45° field of view.
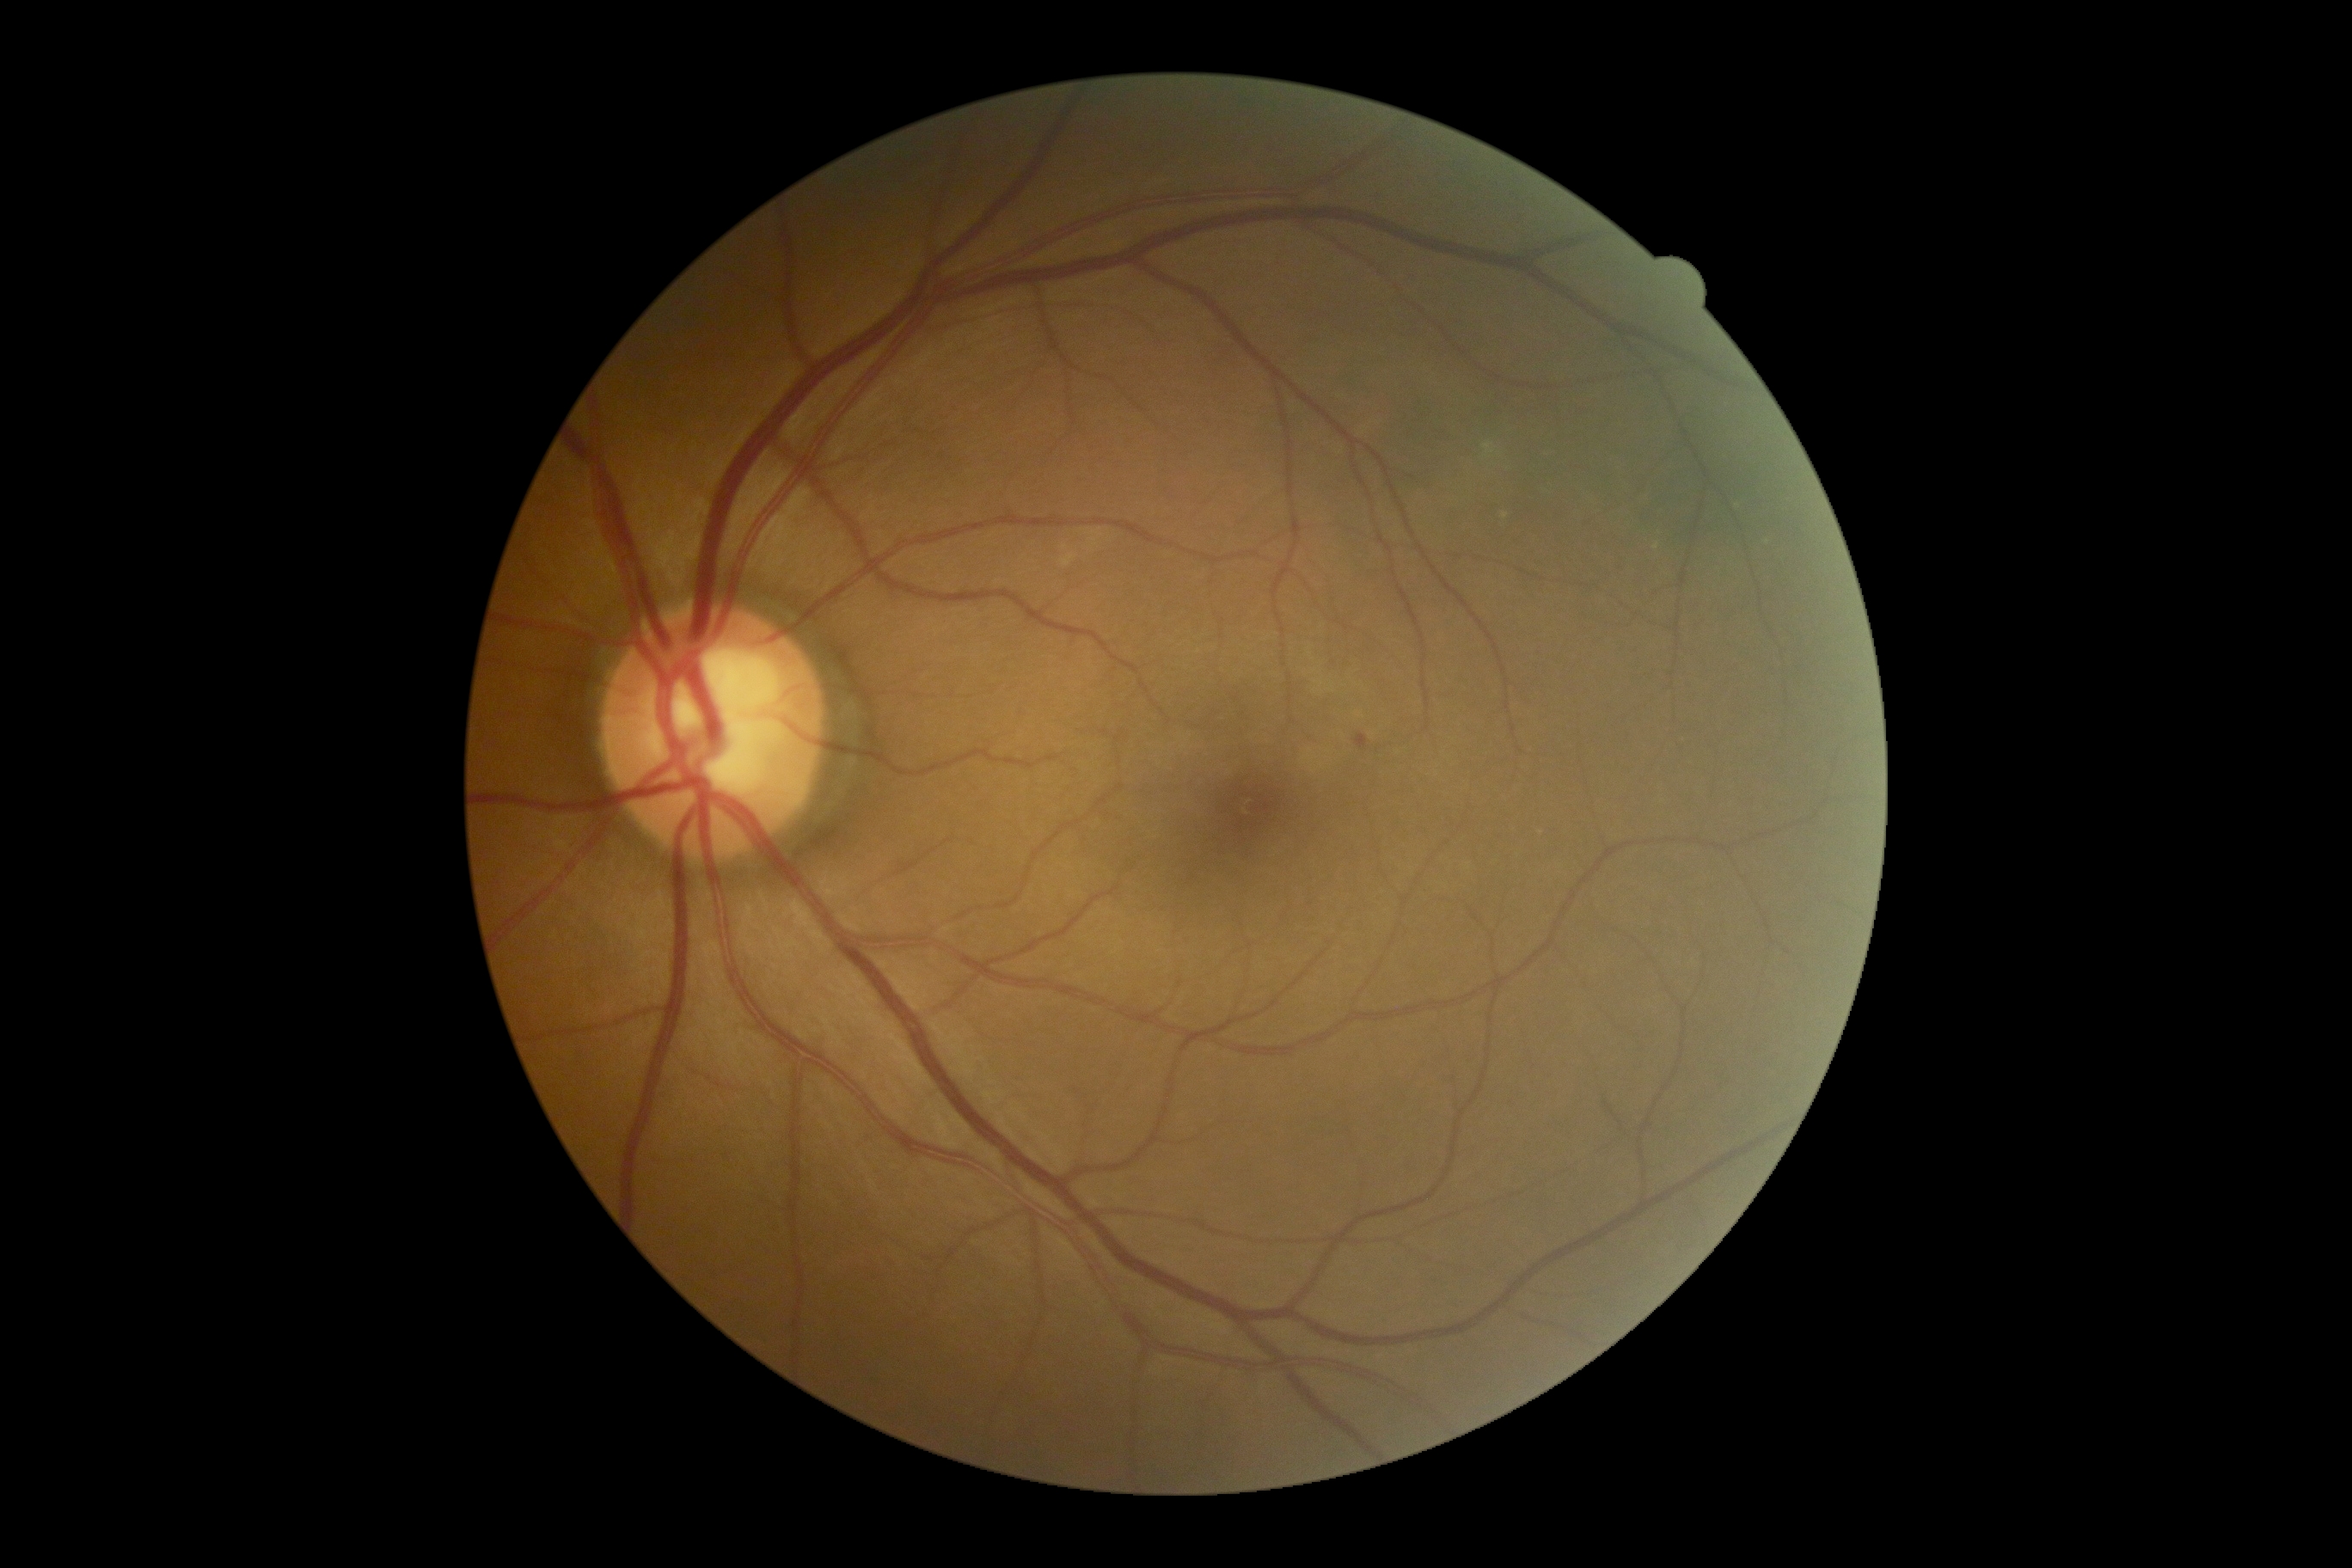
Diabetic retinopathy (DR) is grade 2 (moderate NPDR).